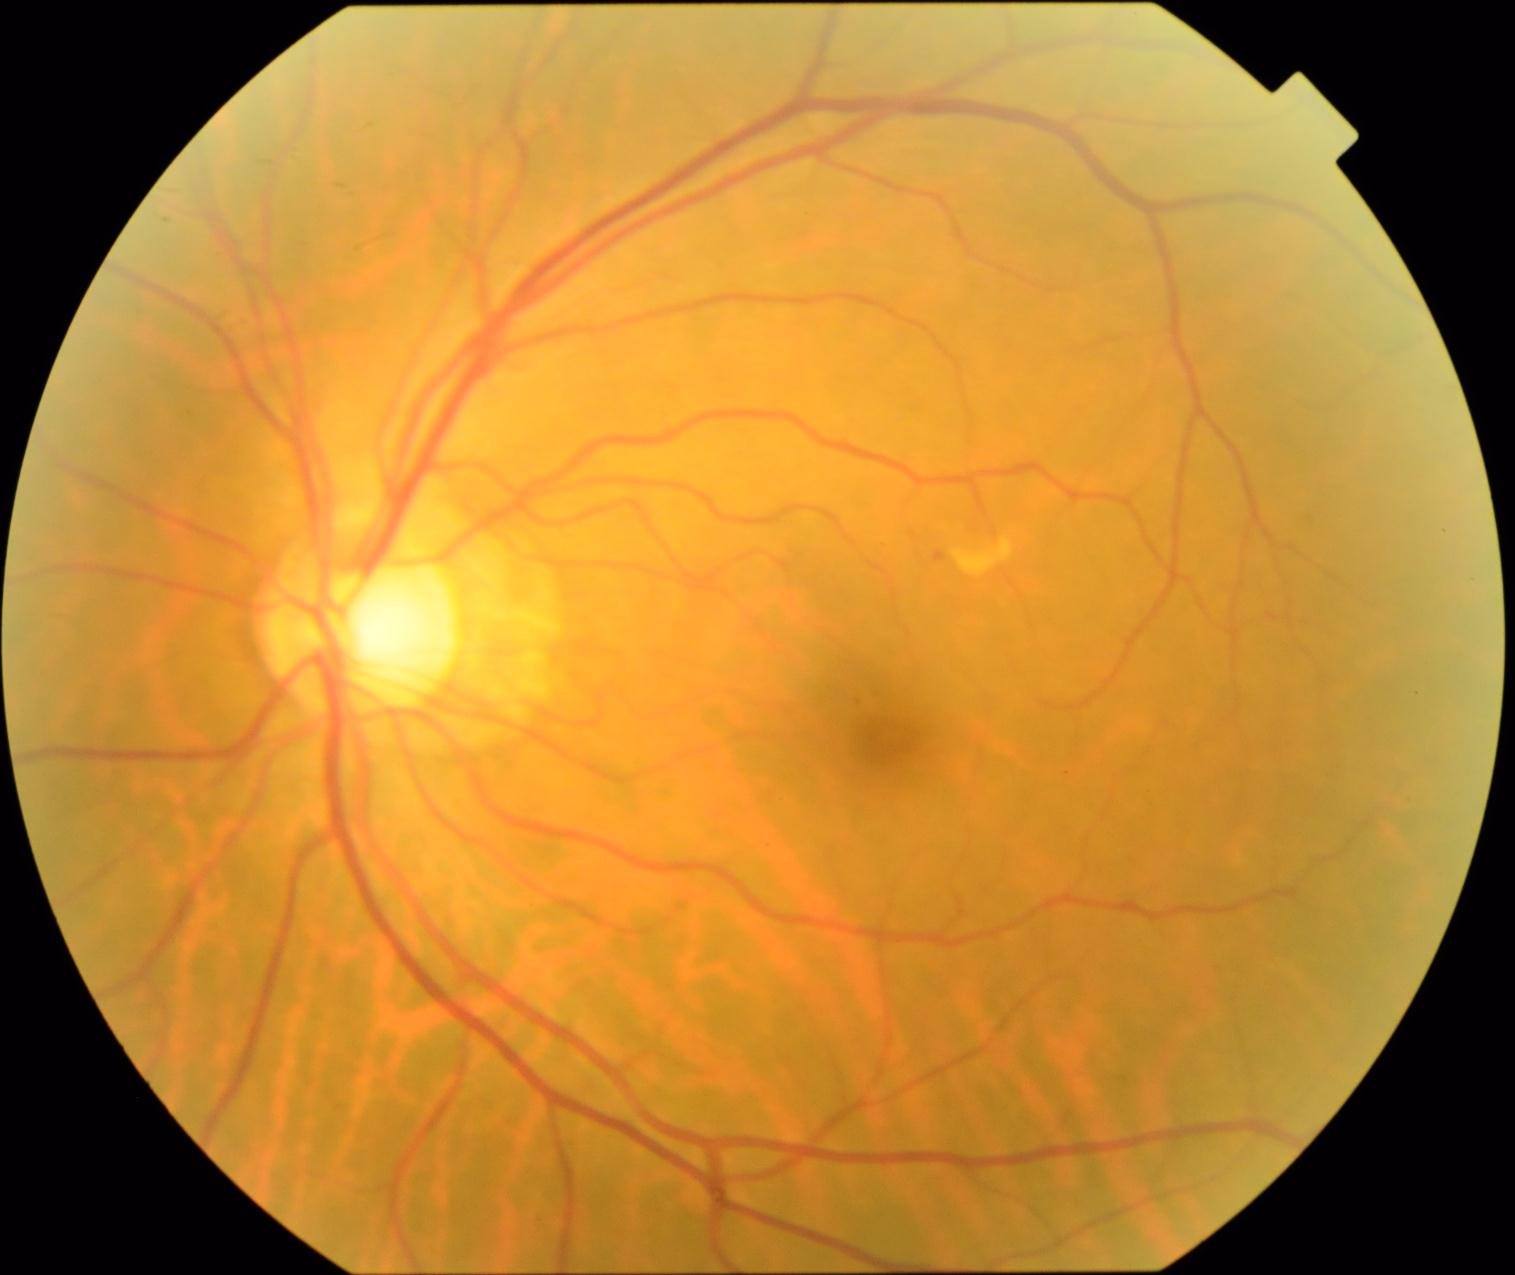 Diabetic retinopathy grade: moderate non-proliferative diabetic retinopathy (2) — more than just microaneurysms but less than severe NPDR. The retinopathy is classified as non-proliferative diabetic retinopathy.